200° FOV · 1924x1556 · wide-field retinal mosaic image:
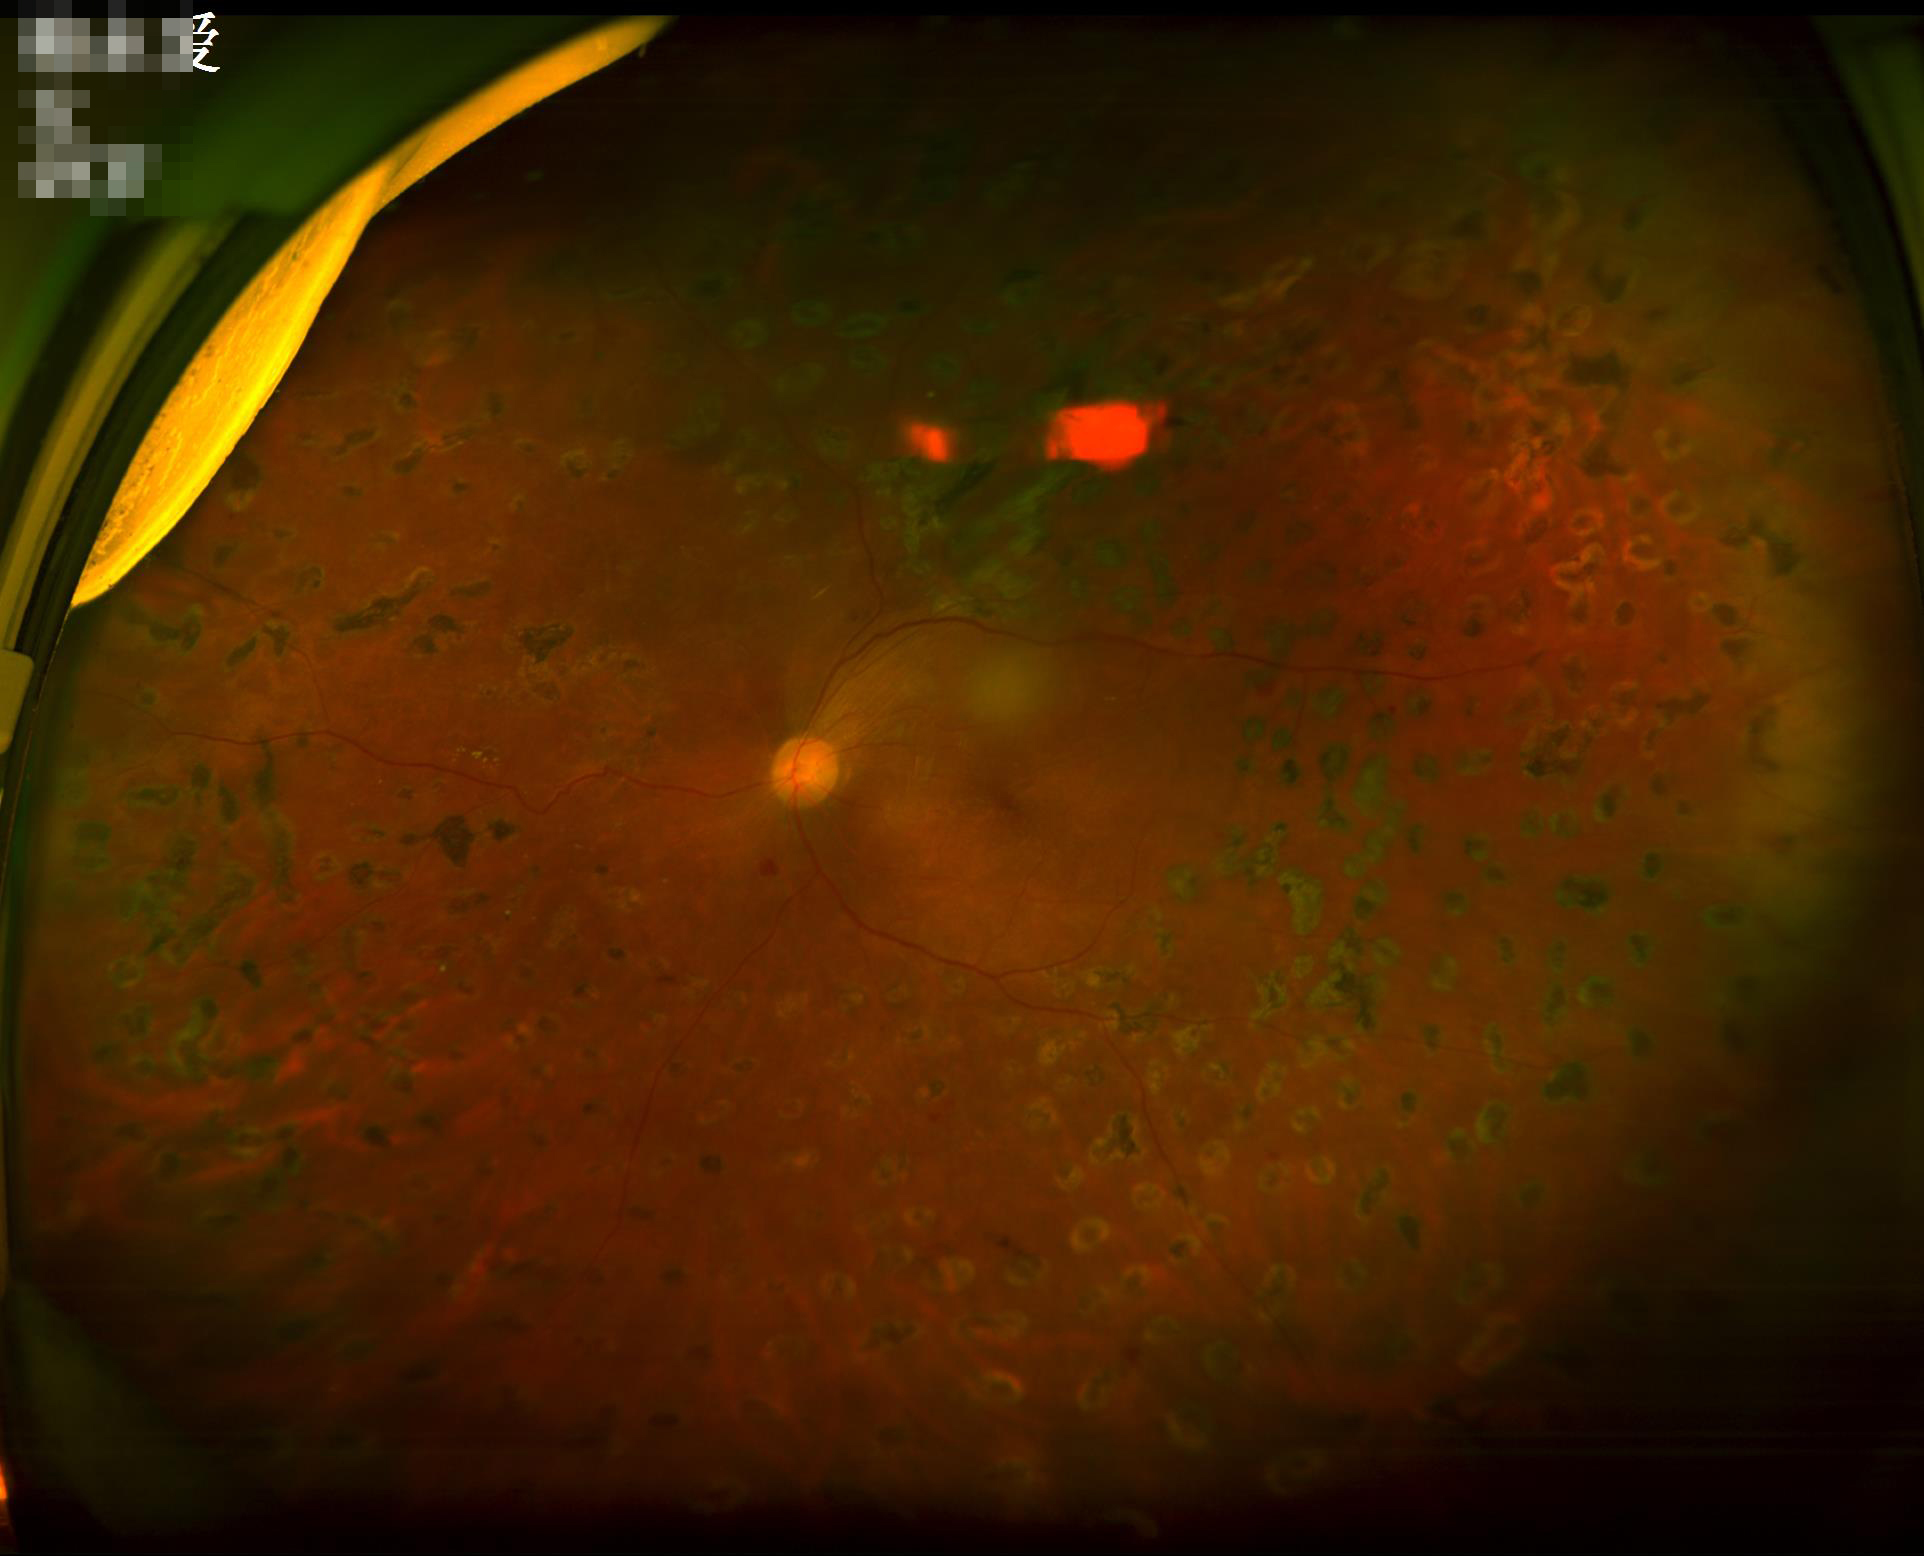

Image quality:
- illumination/color: poor
- overall: low
- sharpness: out of focus
- contrast: satisfactory